Acquired with a NIDEK AFC-230, color fundus photograph: 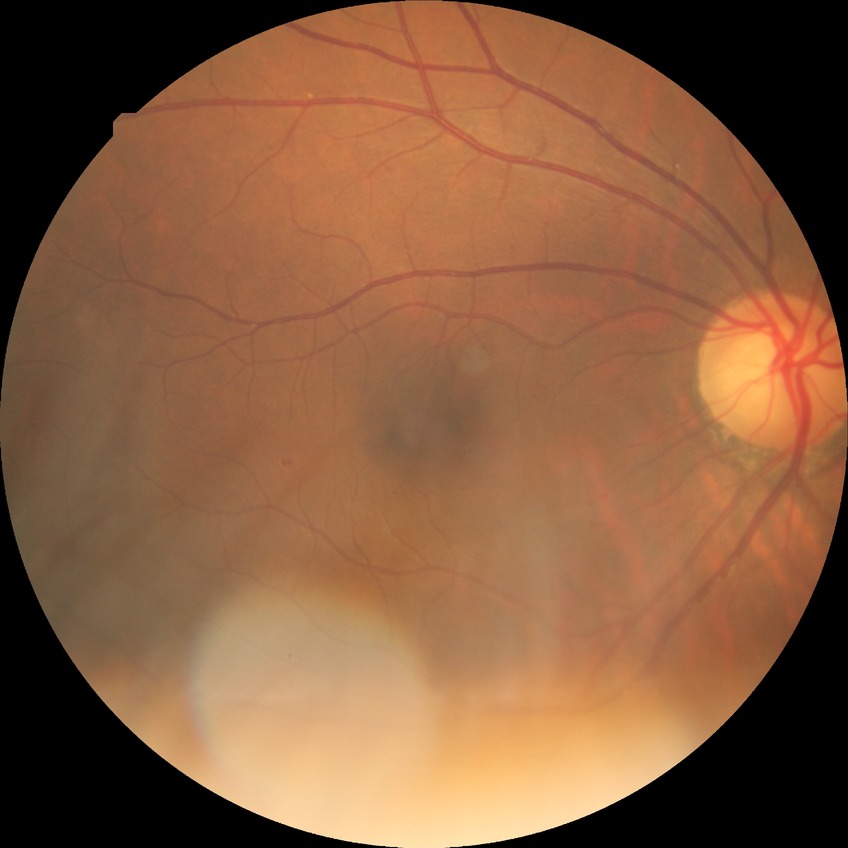
Diabetic retinopathy (DR): SDR (simple diabetic retinopathy).